Posterior pole photograph · modified Davis grading · 848x848 — 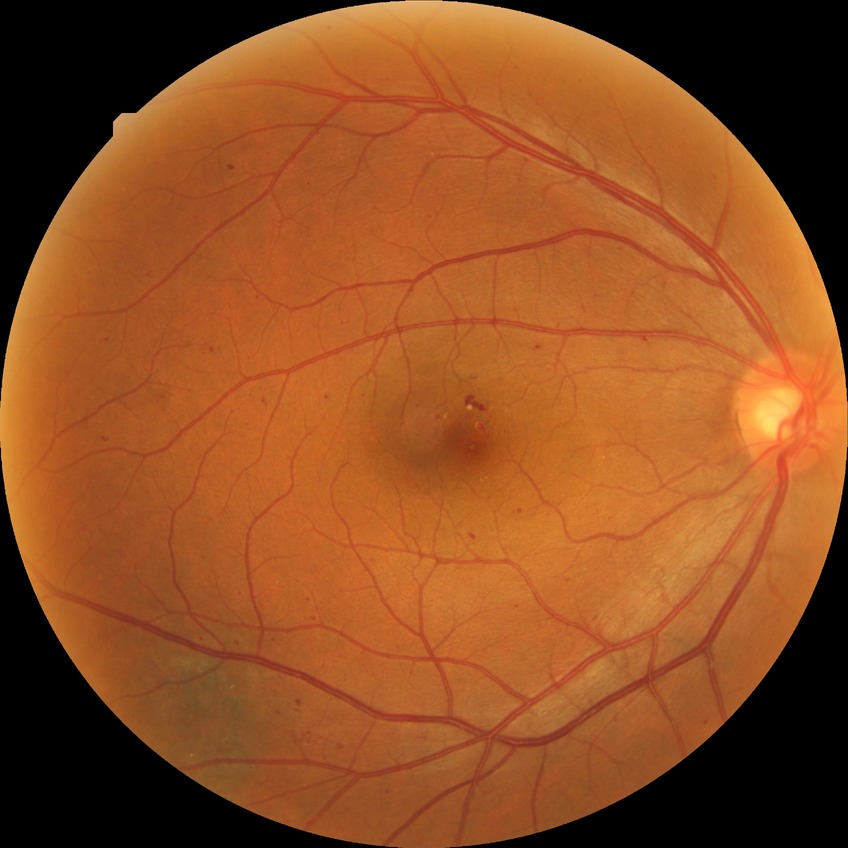
diabetic retinopathy (DR)@SDR (simple diabetic retinopathy).